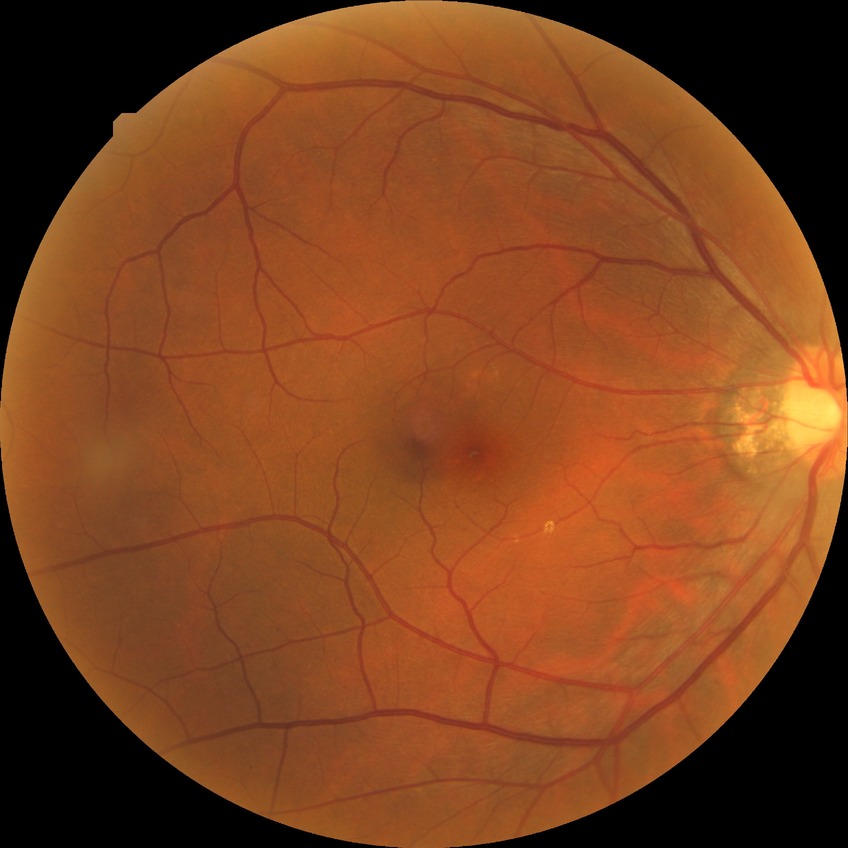

Diabetic retinopathy (DR) is no diabetic retinopathy (NDR).